45° FOV. 2048x1536. Fundus photo:
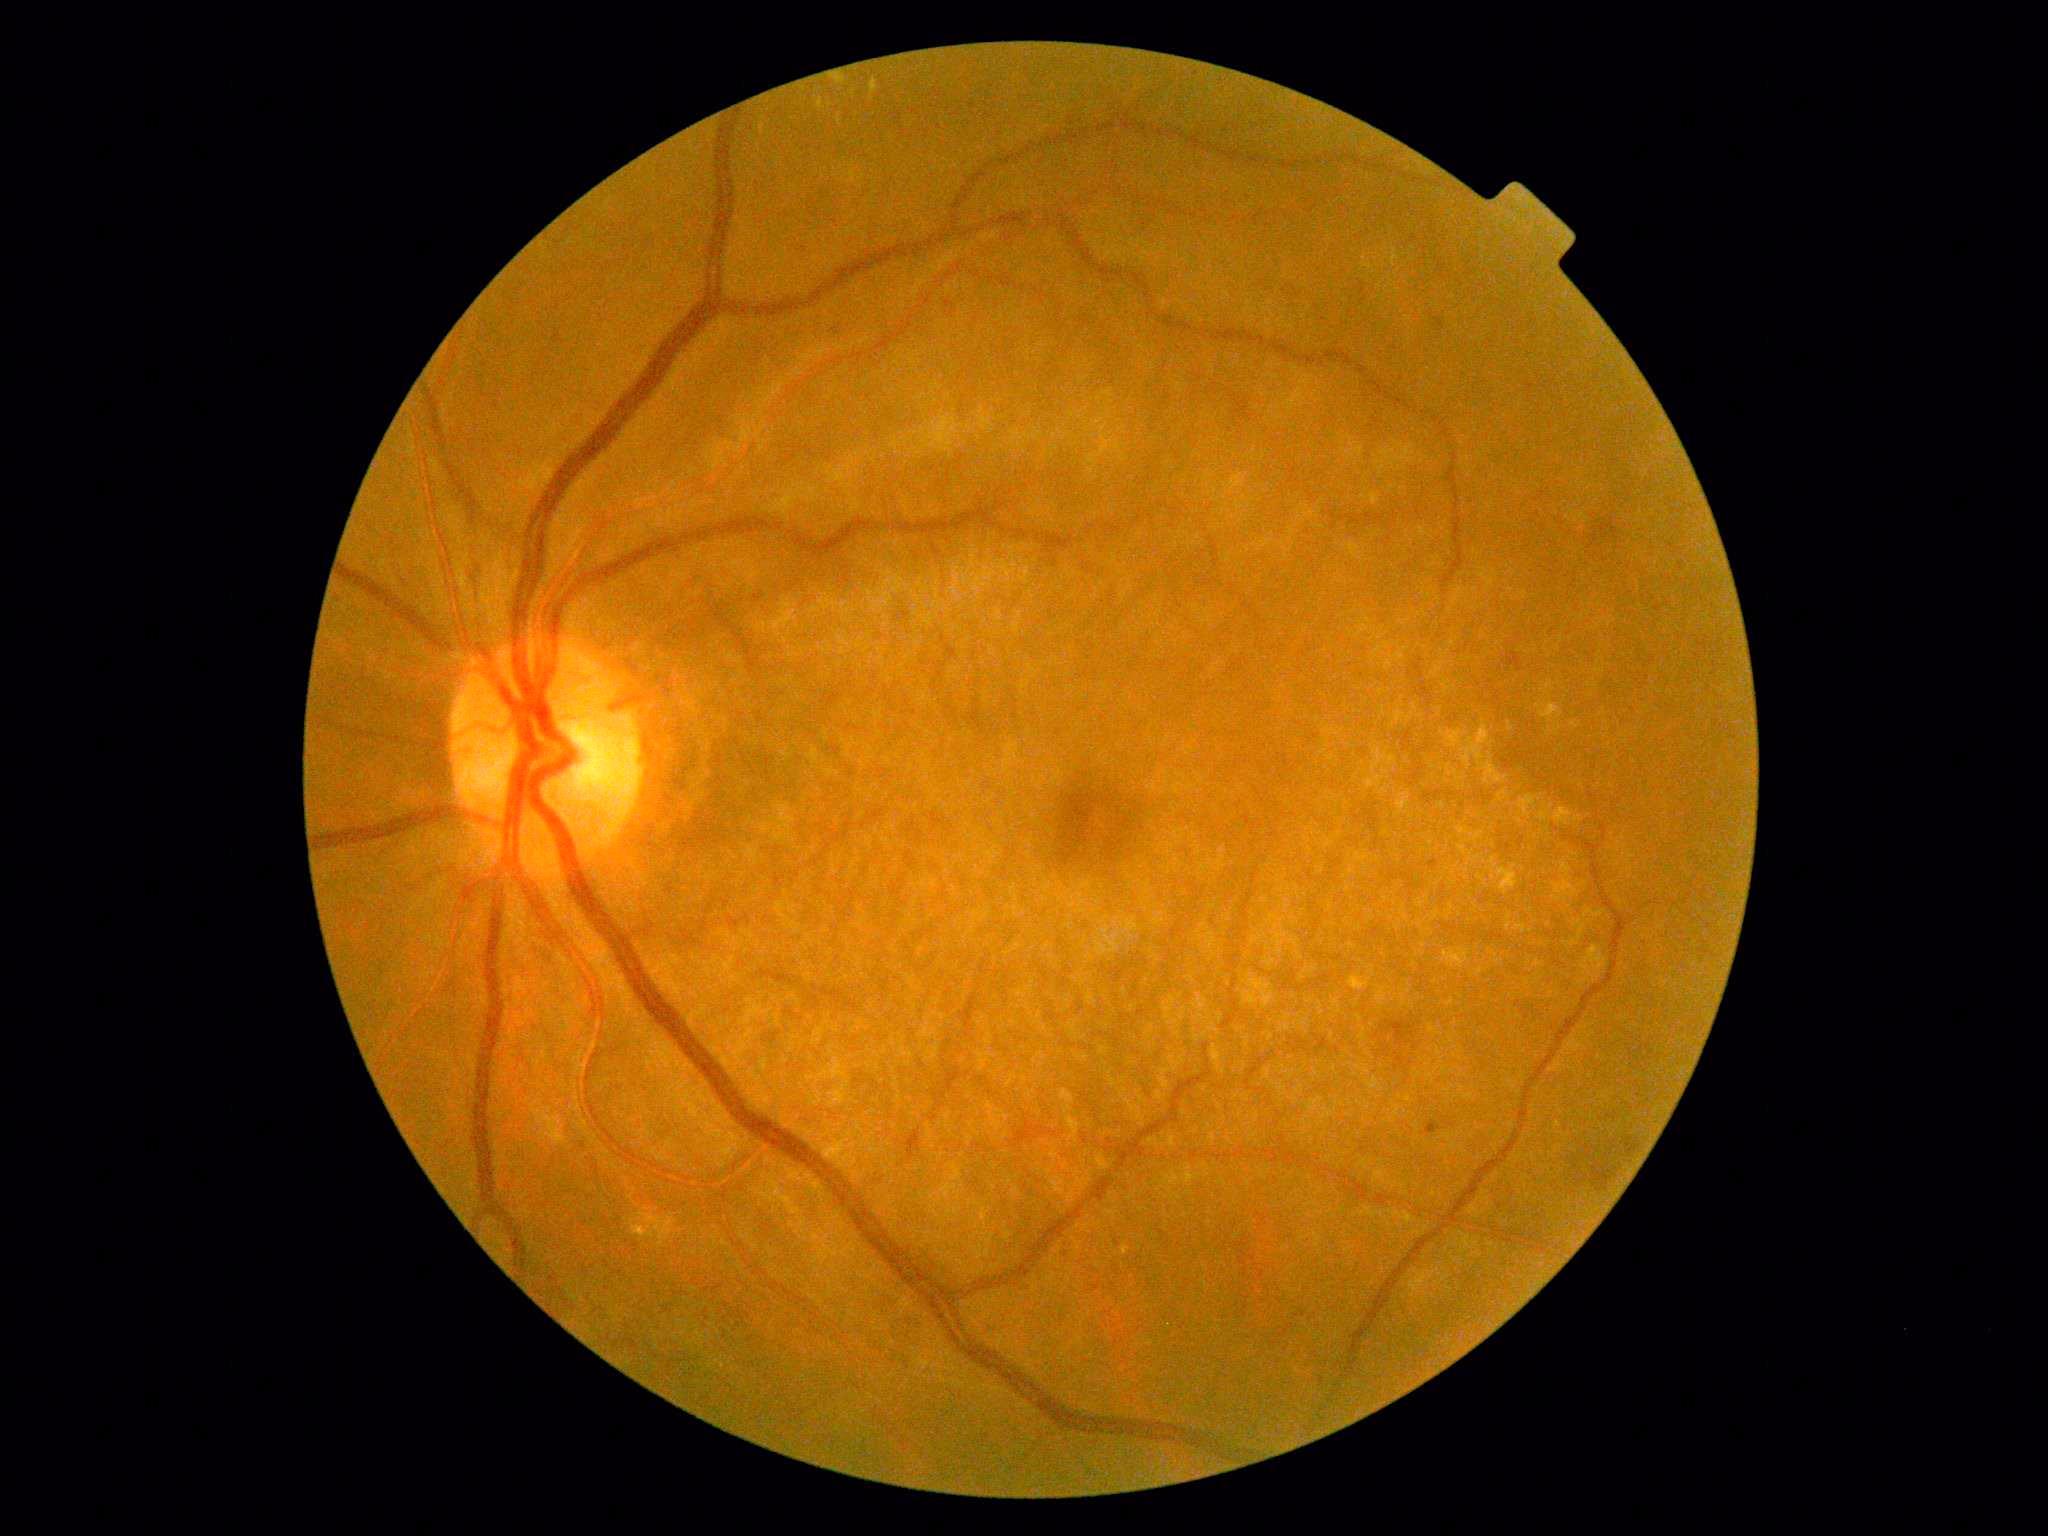 DR stage: moderate non-proliferative diabetic retinopathy (grade 2)
DR class: non-proliferative diabetic retinopathy